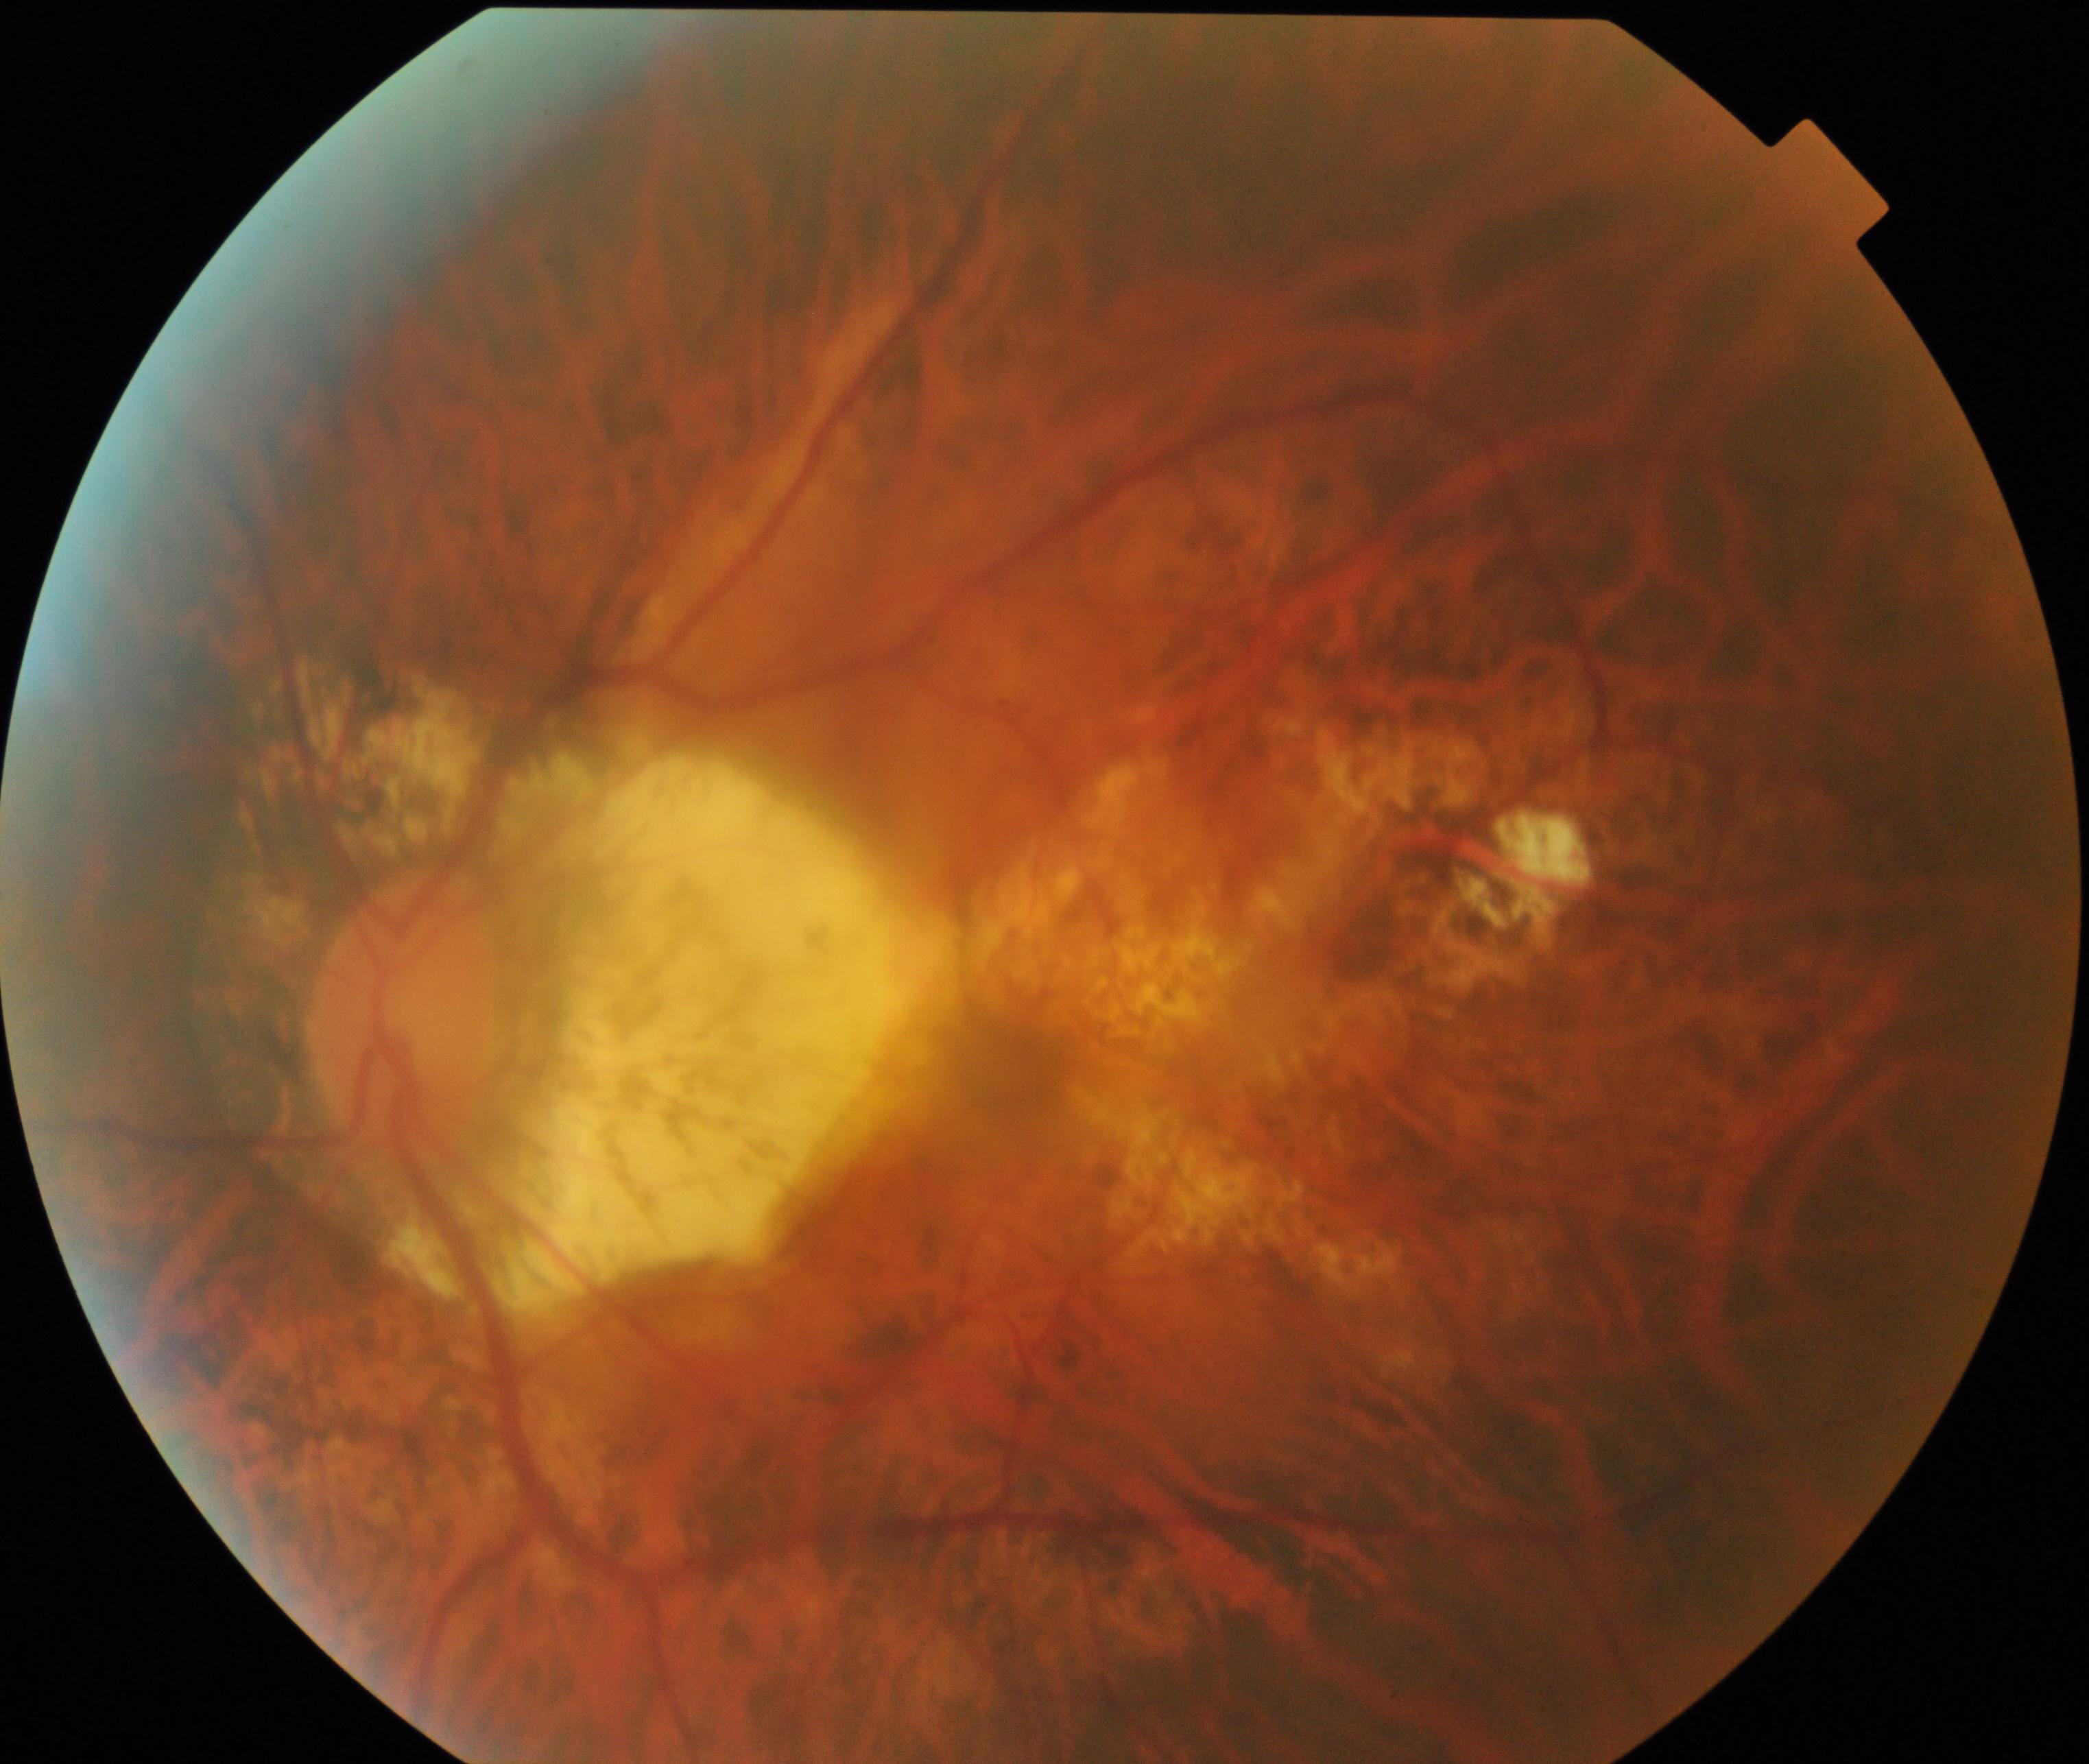

Diagnosis: pathological myopia.